Fundus photo. Non-mydriatic.
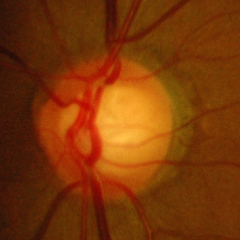
Glaucomatous changes are present. Glaucoma diagnosis = advanced-stage glaucoma. (Criteria: near-total cupping of the optic nerve head, with or without severe visual field loss within the central 10 degrees of fixation.)